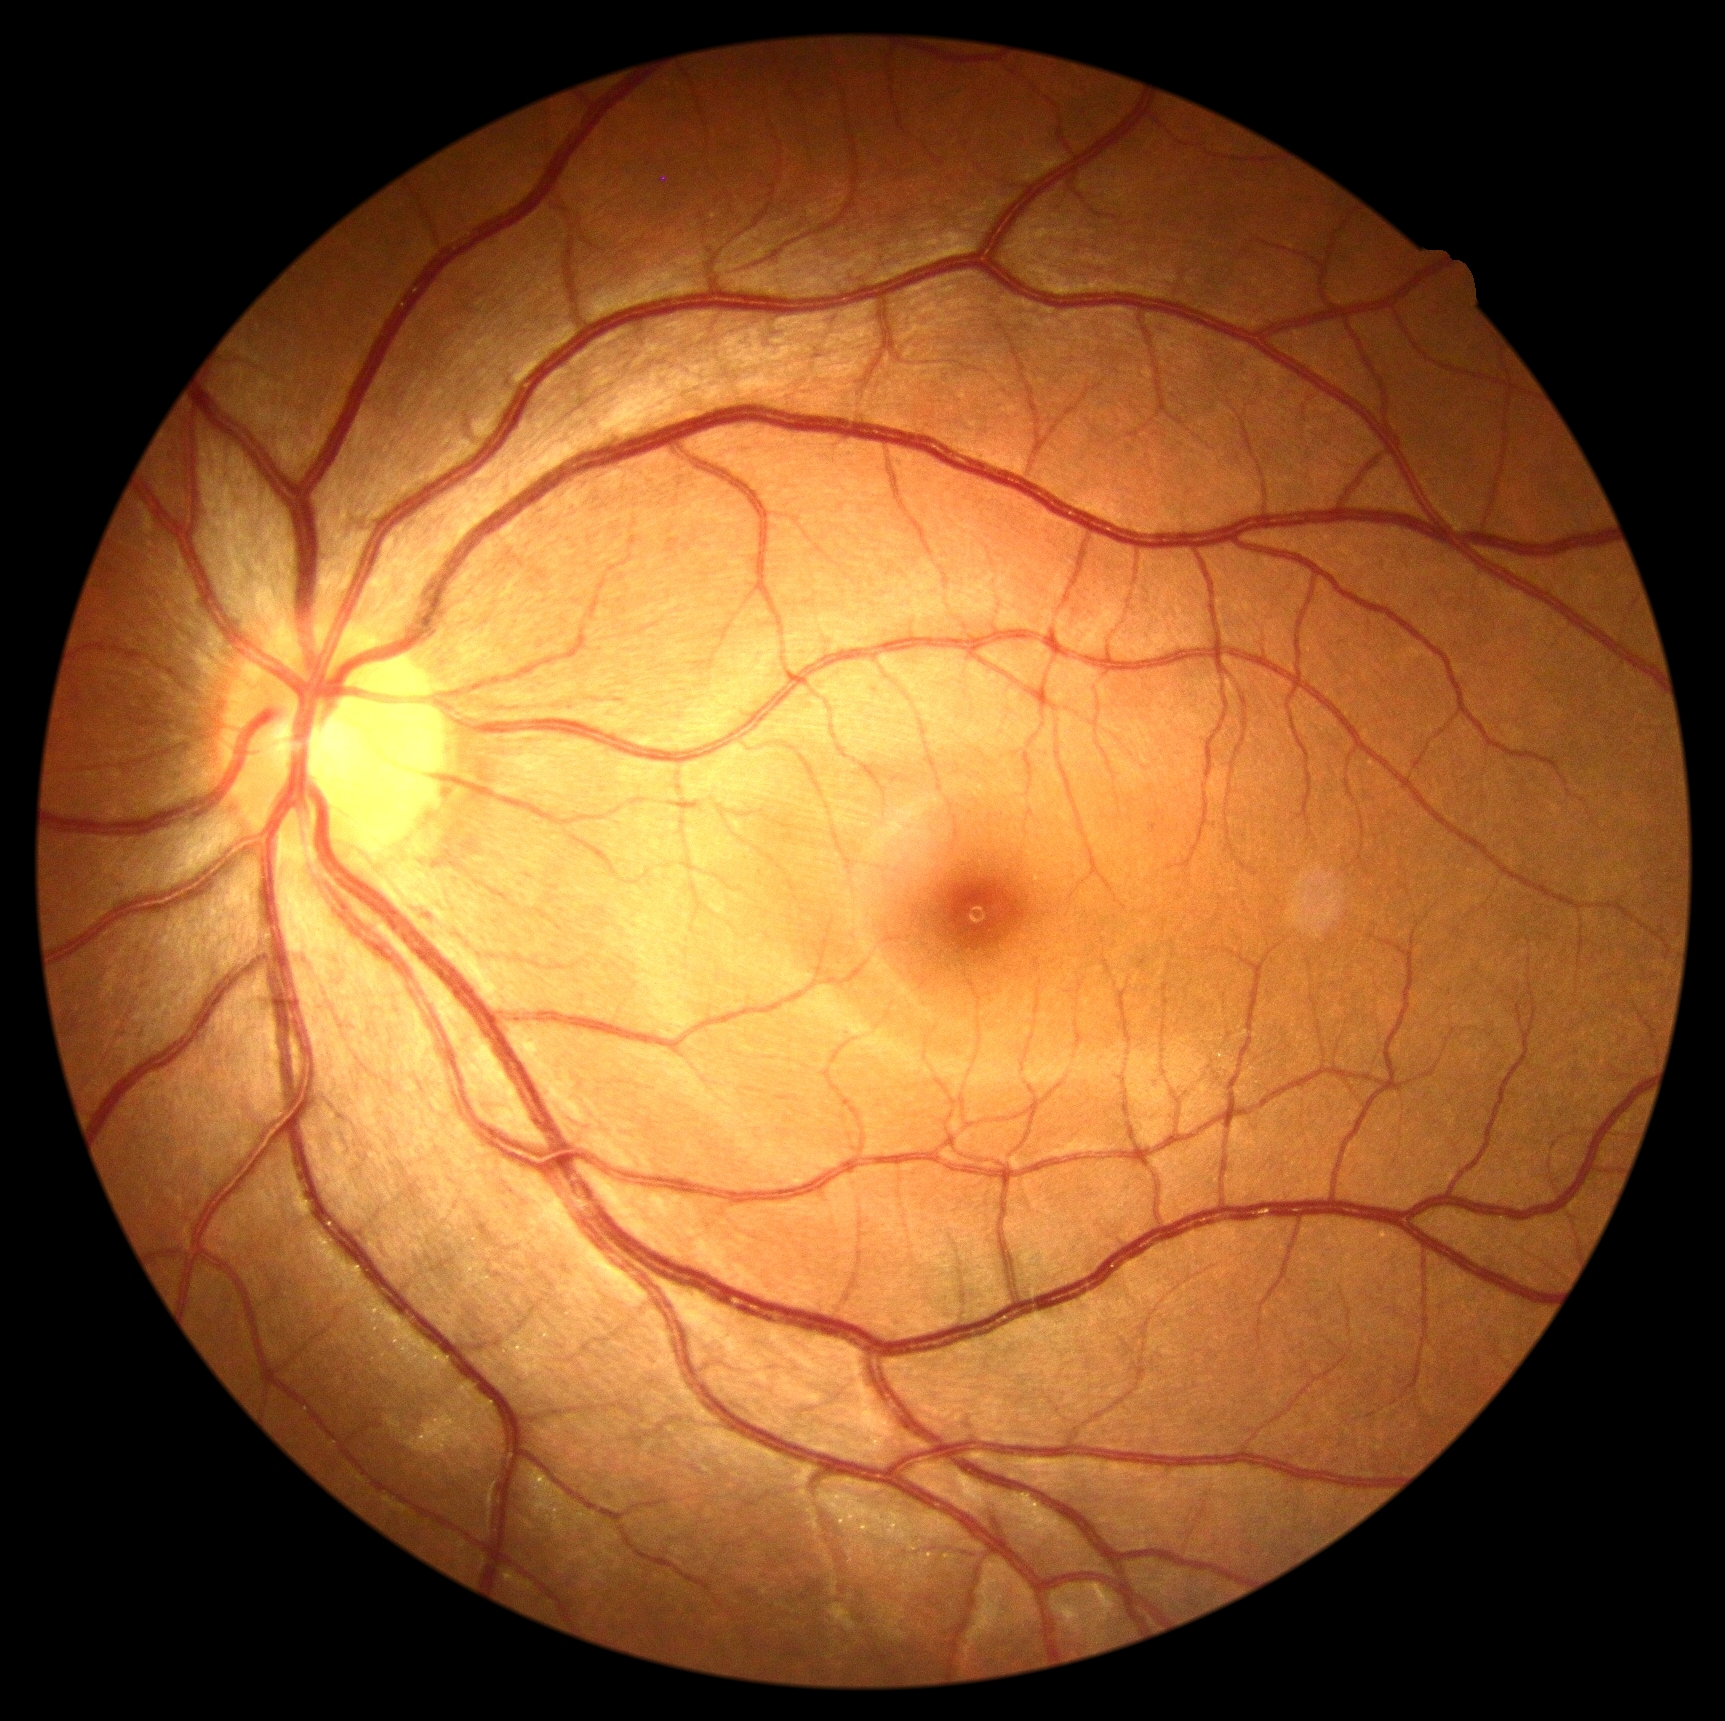 Diabetic retinopathy grade is 0/4. No DR findings.